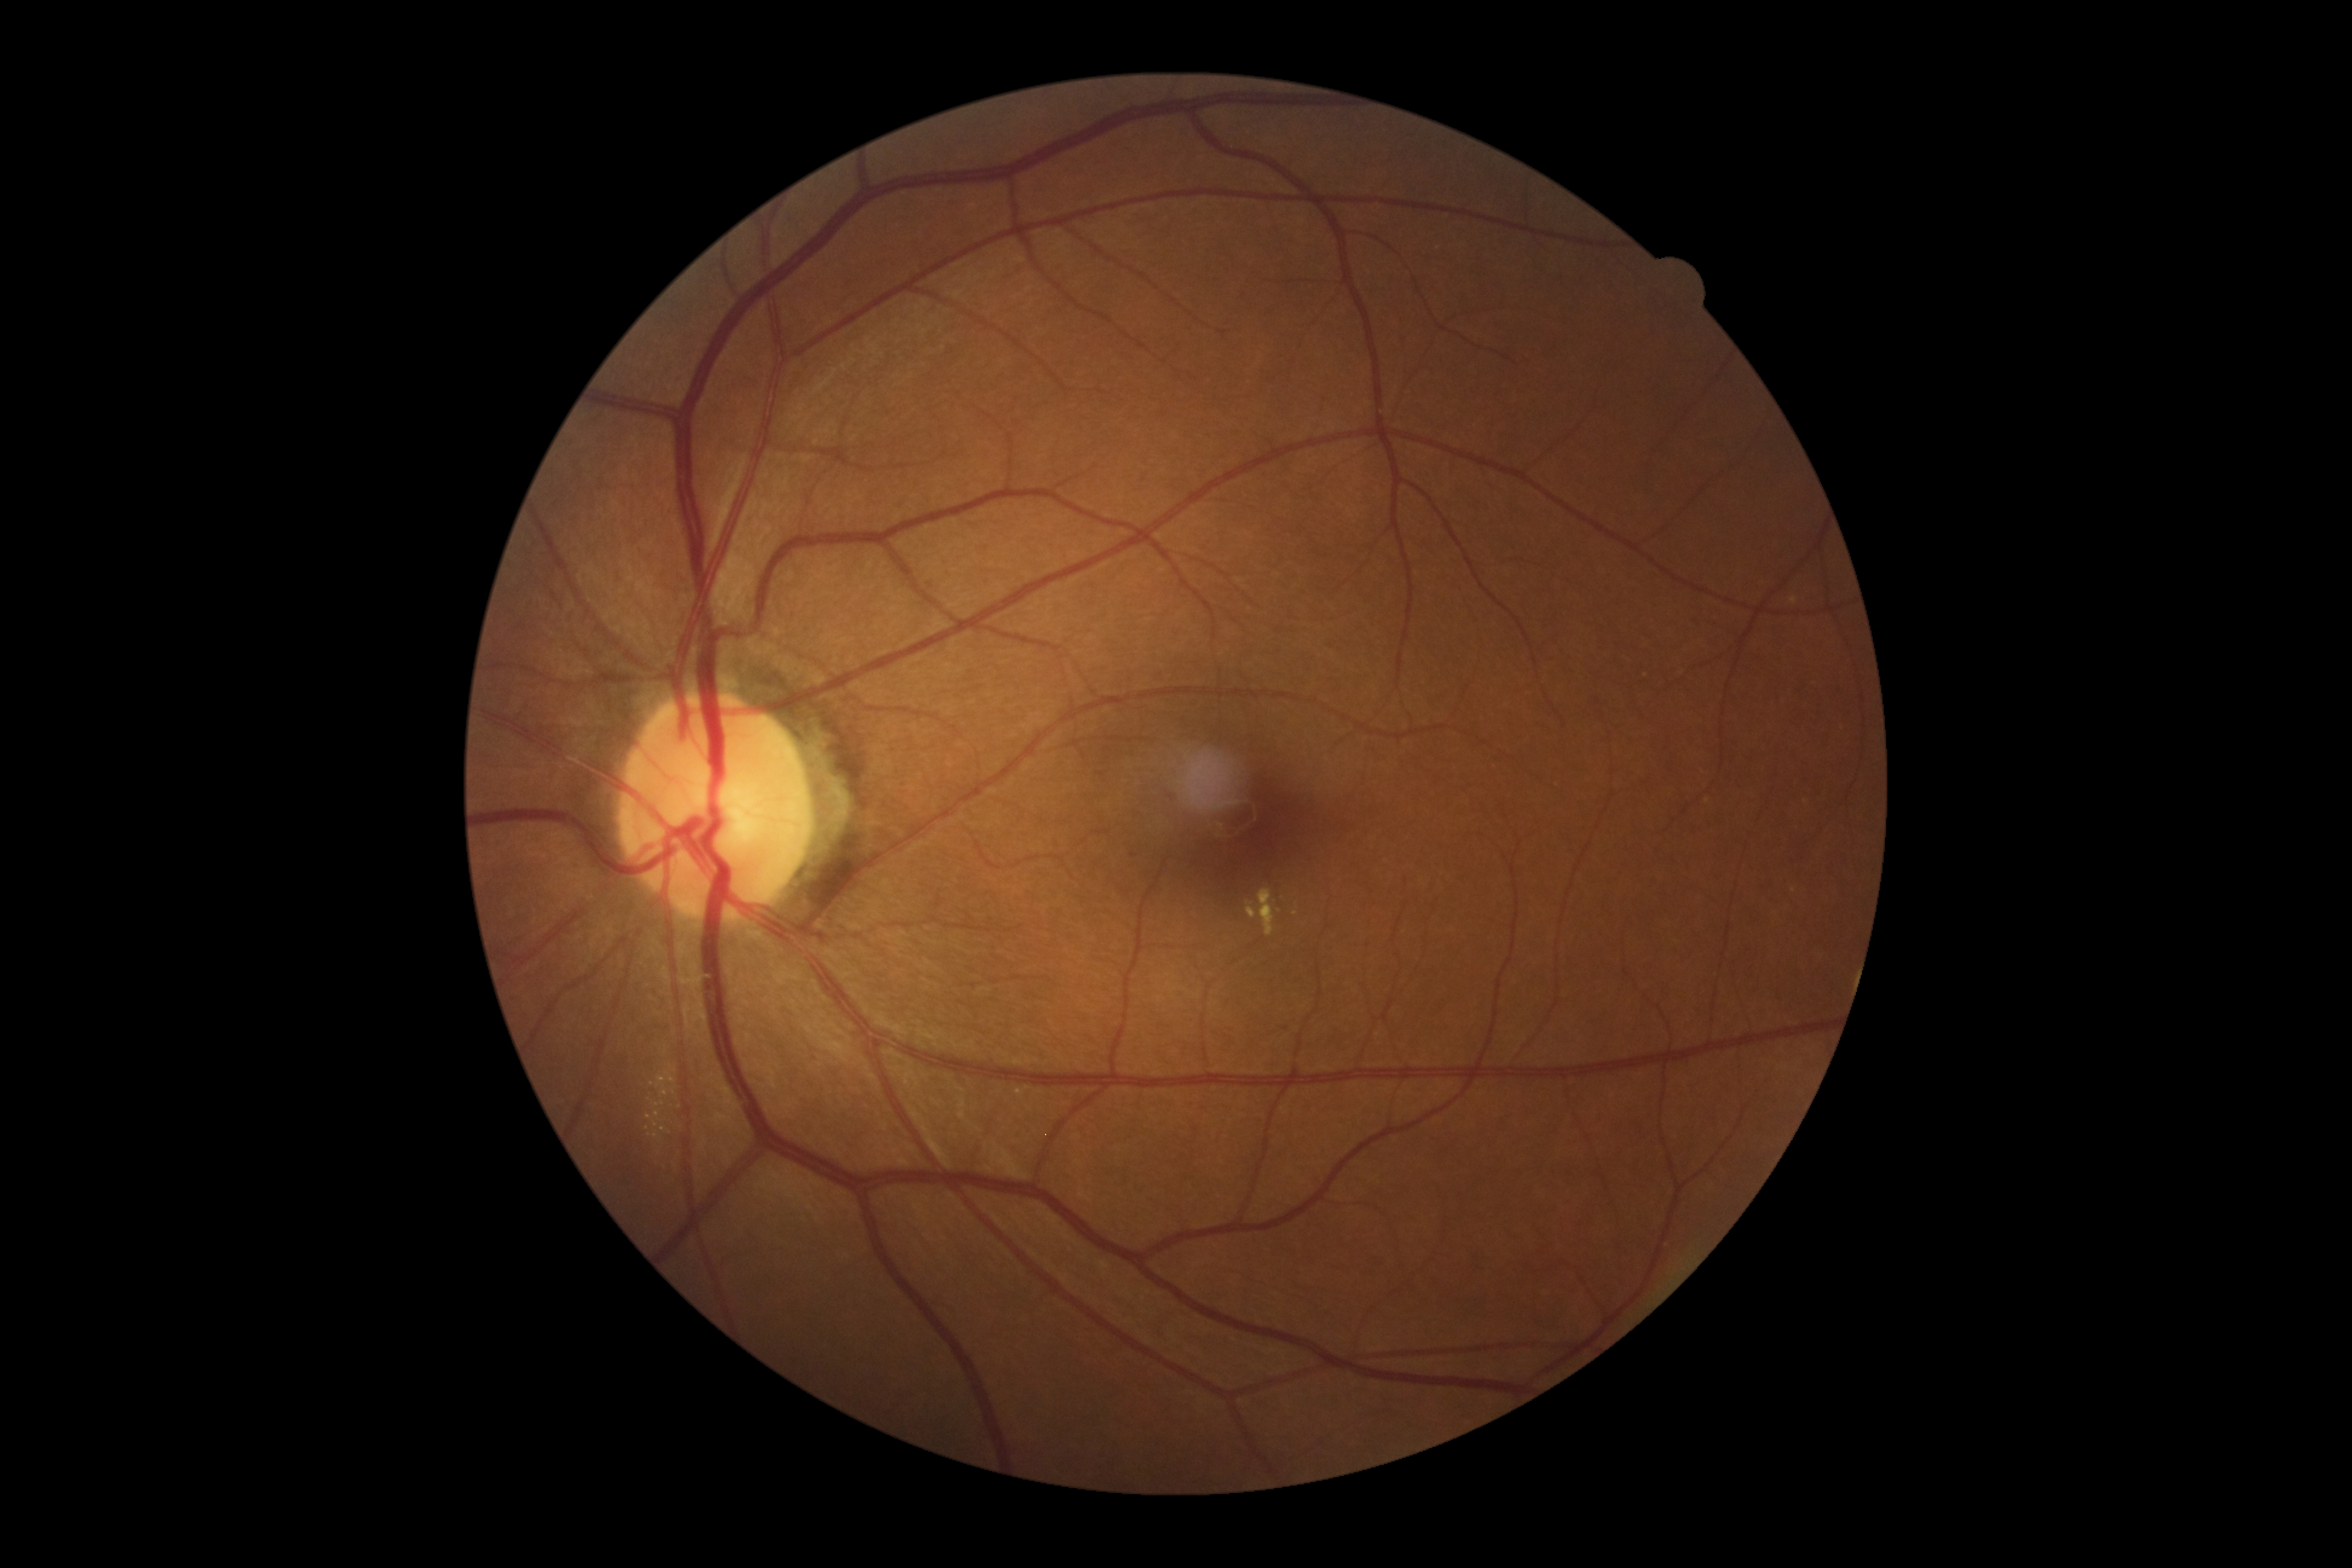
Annotations:
– DR — grade 2